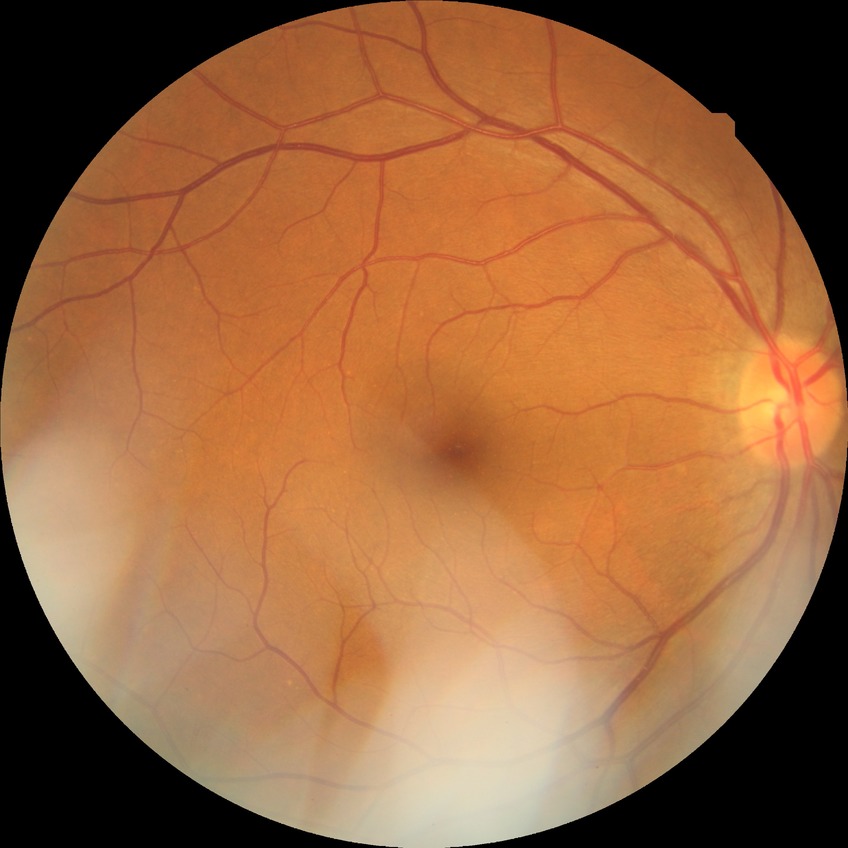 Modified Davis classification: no diabetic retinopathy.